1932x1932px · retinal fundus photograph: 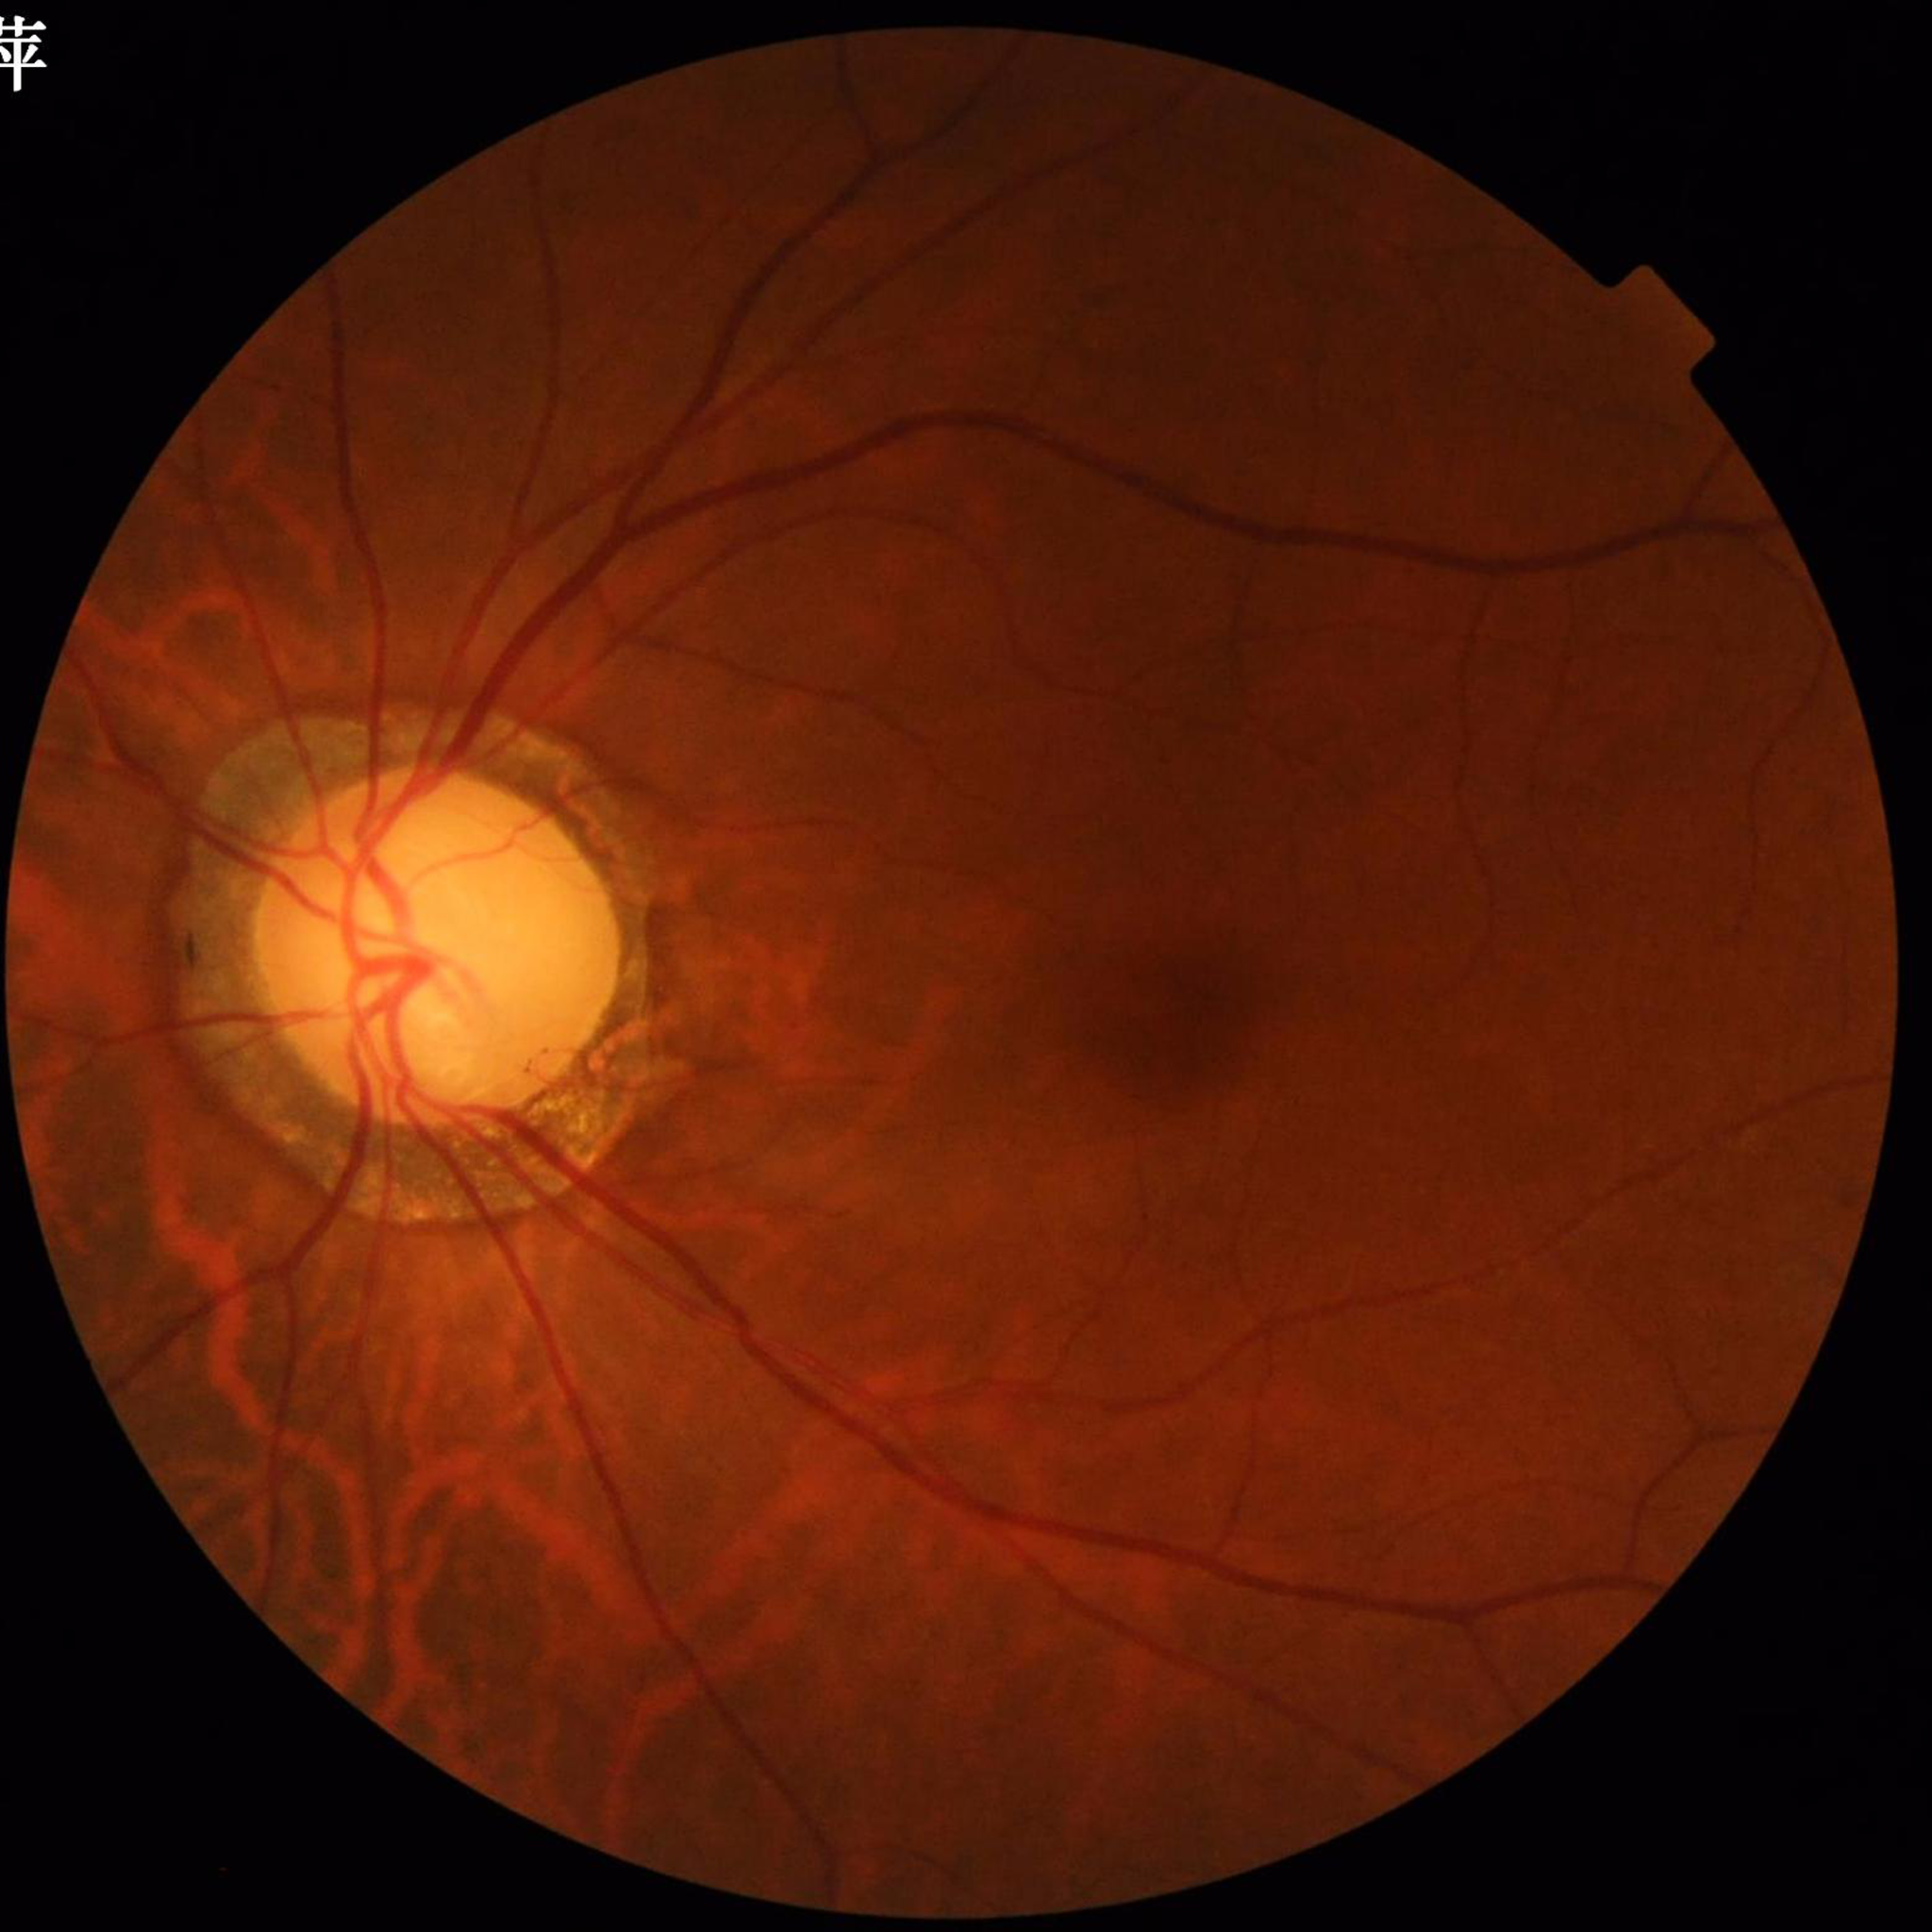

Patient diagnosed with glaucoma.
Quality assessment: no concerns identified.